Image size 848x848; FOV: 45 degrees; modified Davis grading.
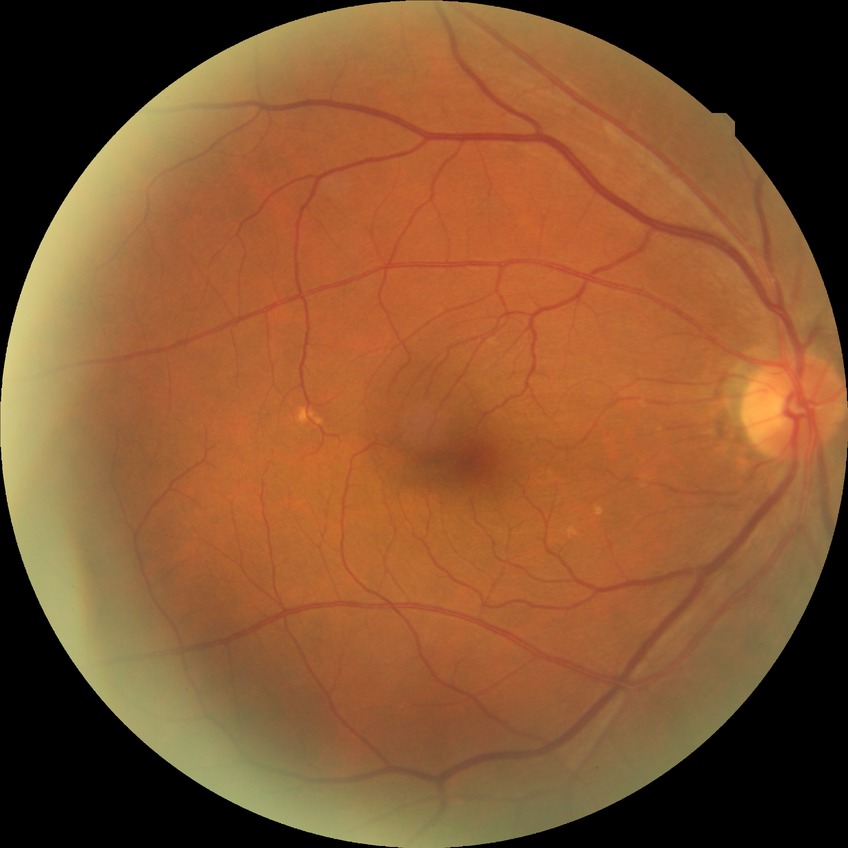

Diabetic retinopathy (DR) is NDR (no diabetic retinopathy).